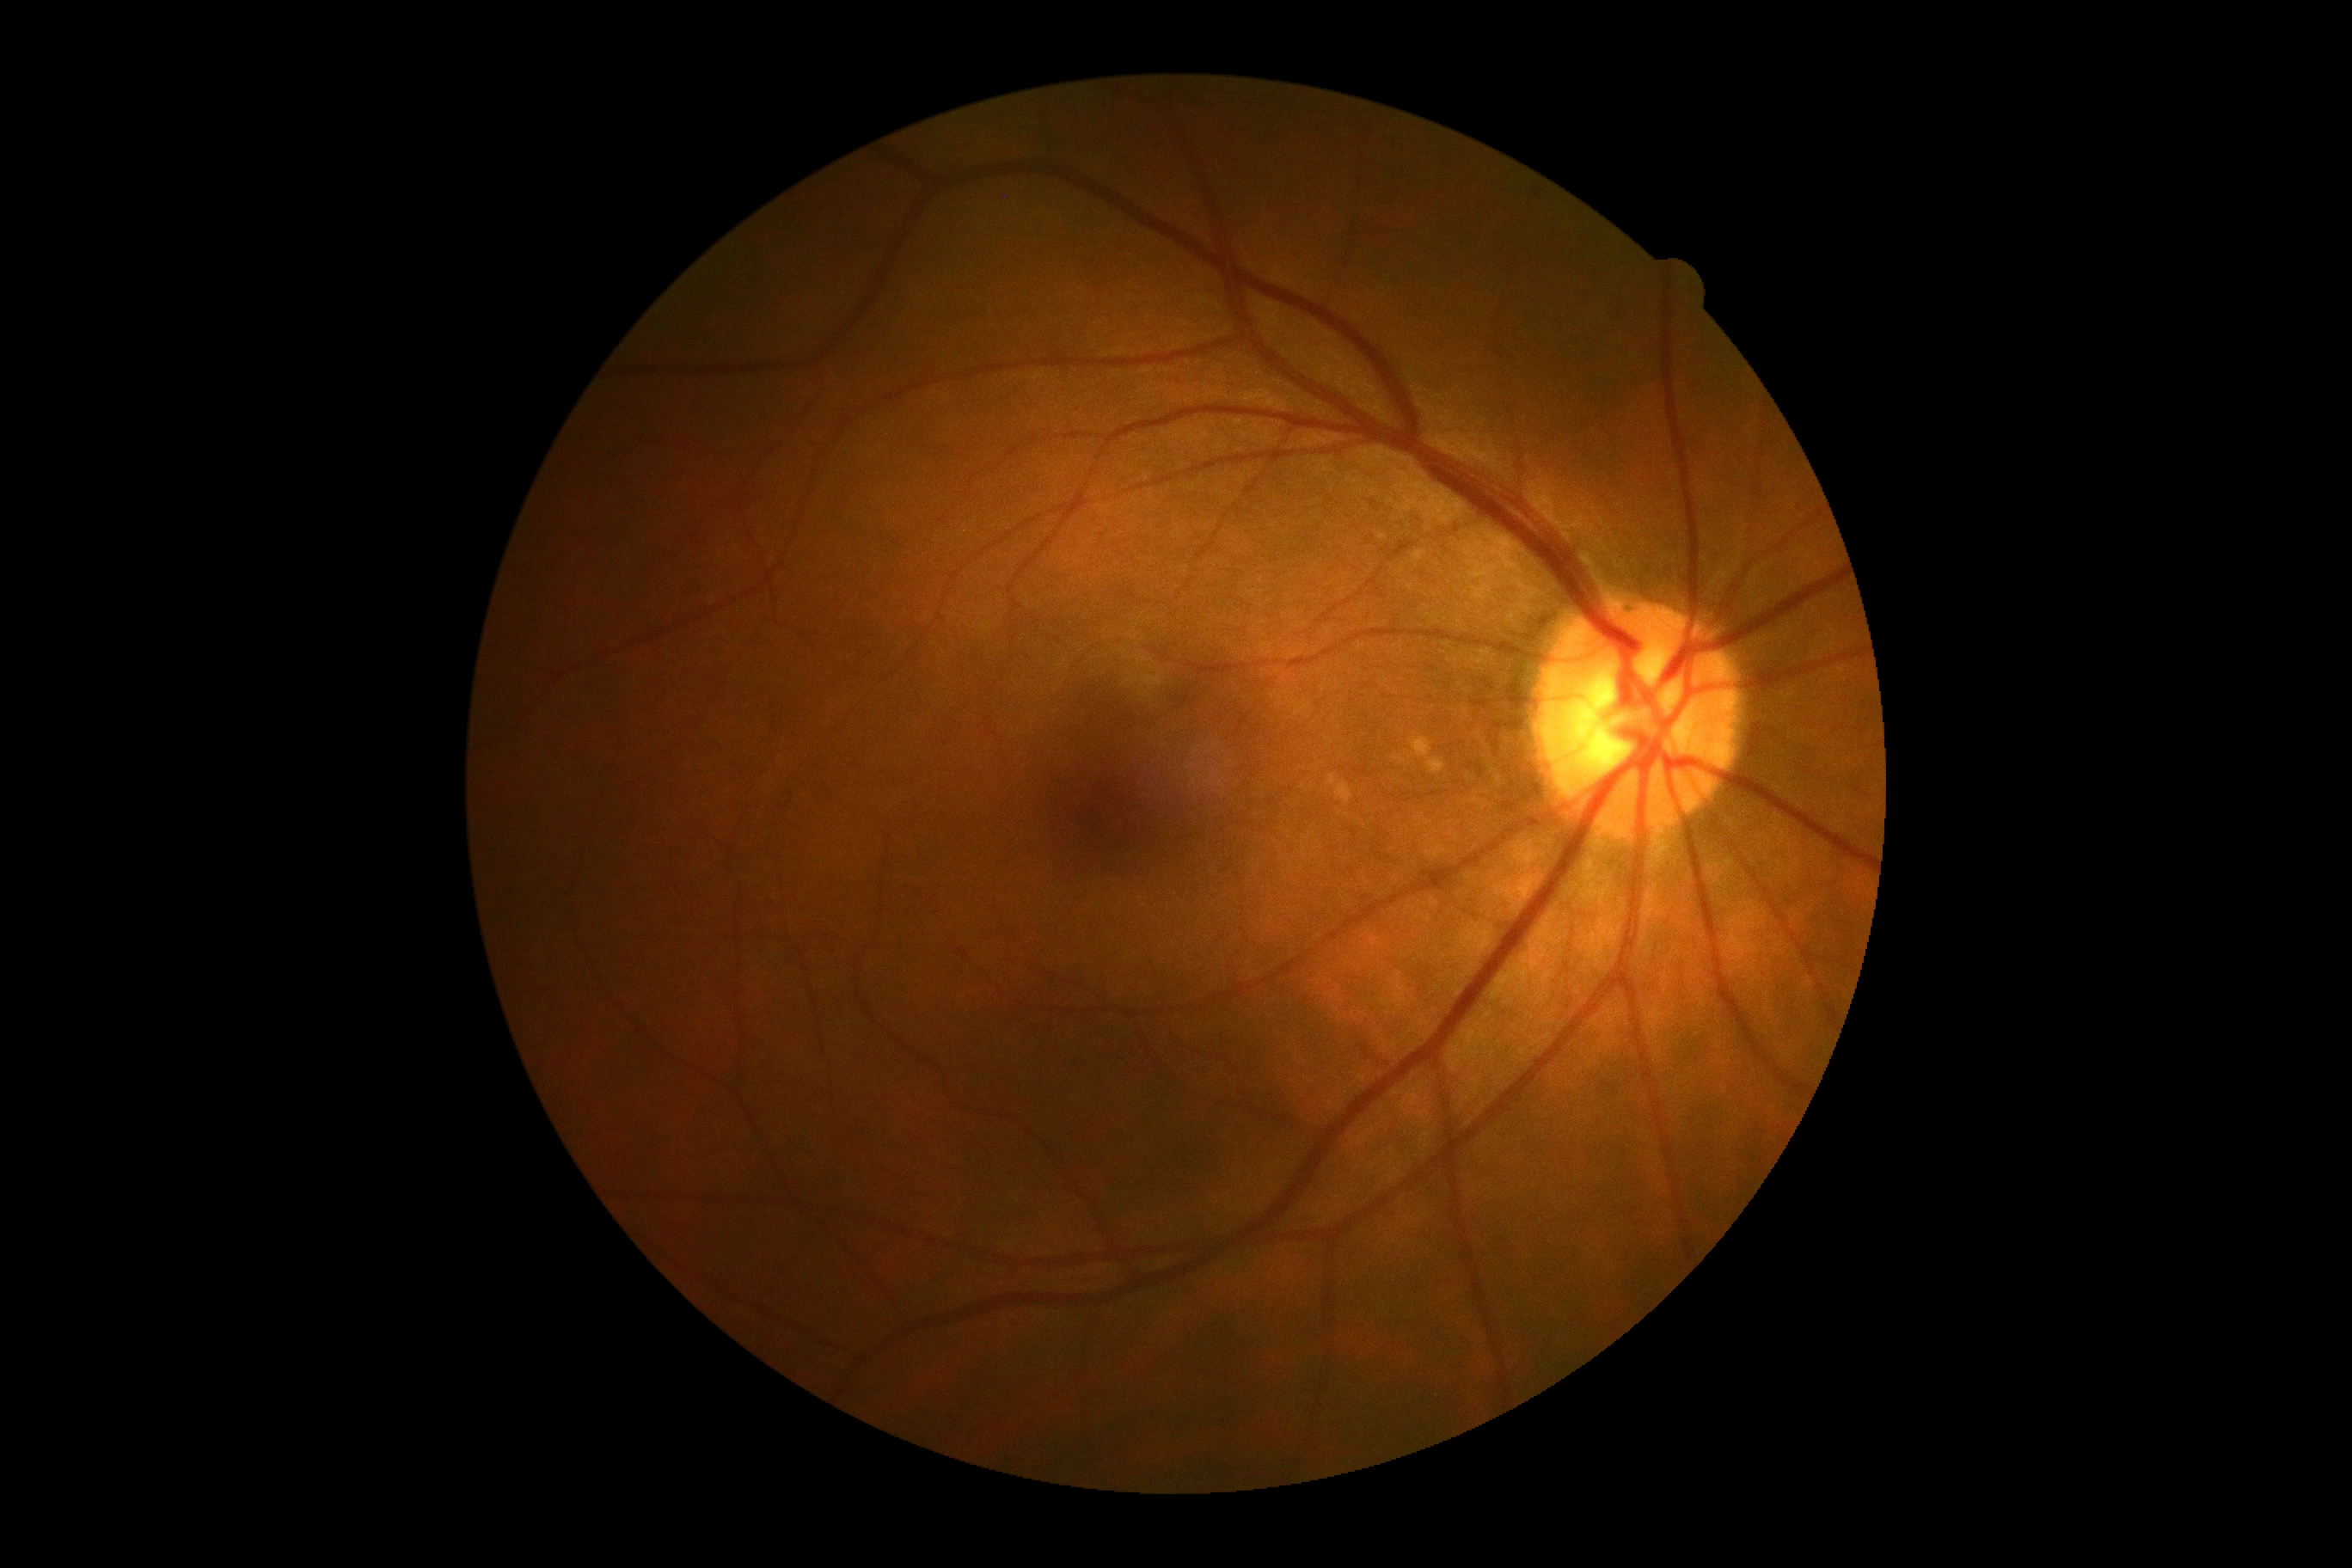 DR stage: grade 0 — no visible signs of diabetic retinopathy.